Diabetic retinopathy graded by the modified Davis classification · posterior pole color fundus photograph: 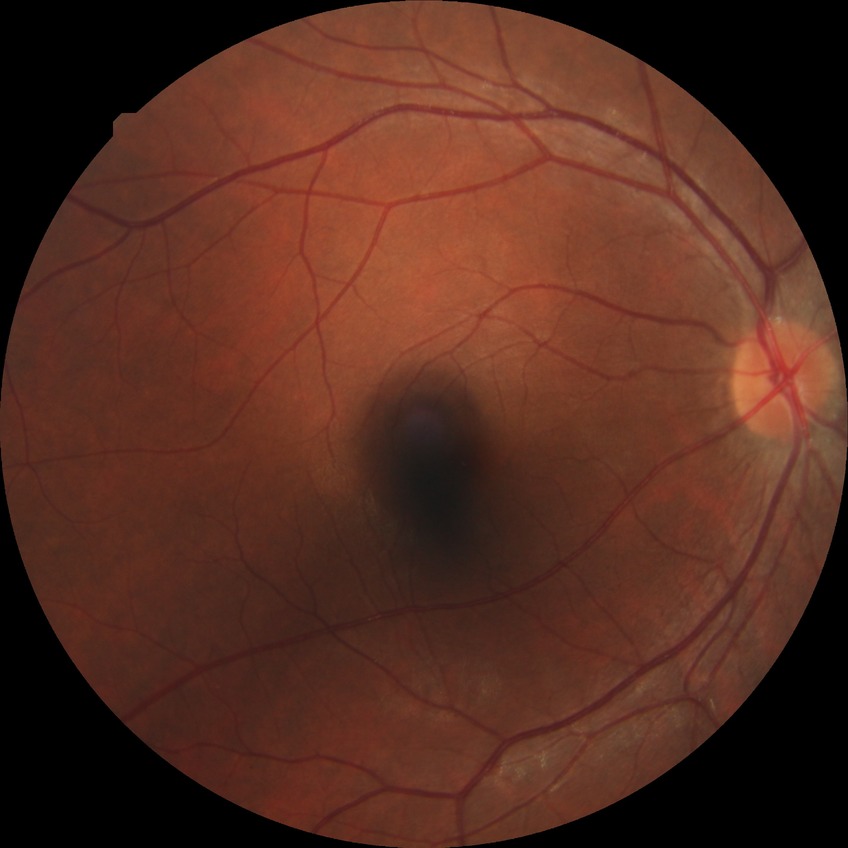
{
  "davis_grade": "no diabetic retinopathy"
}